Color fundus photograph.
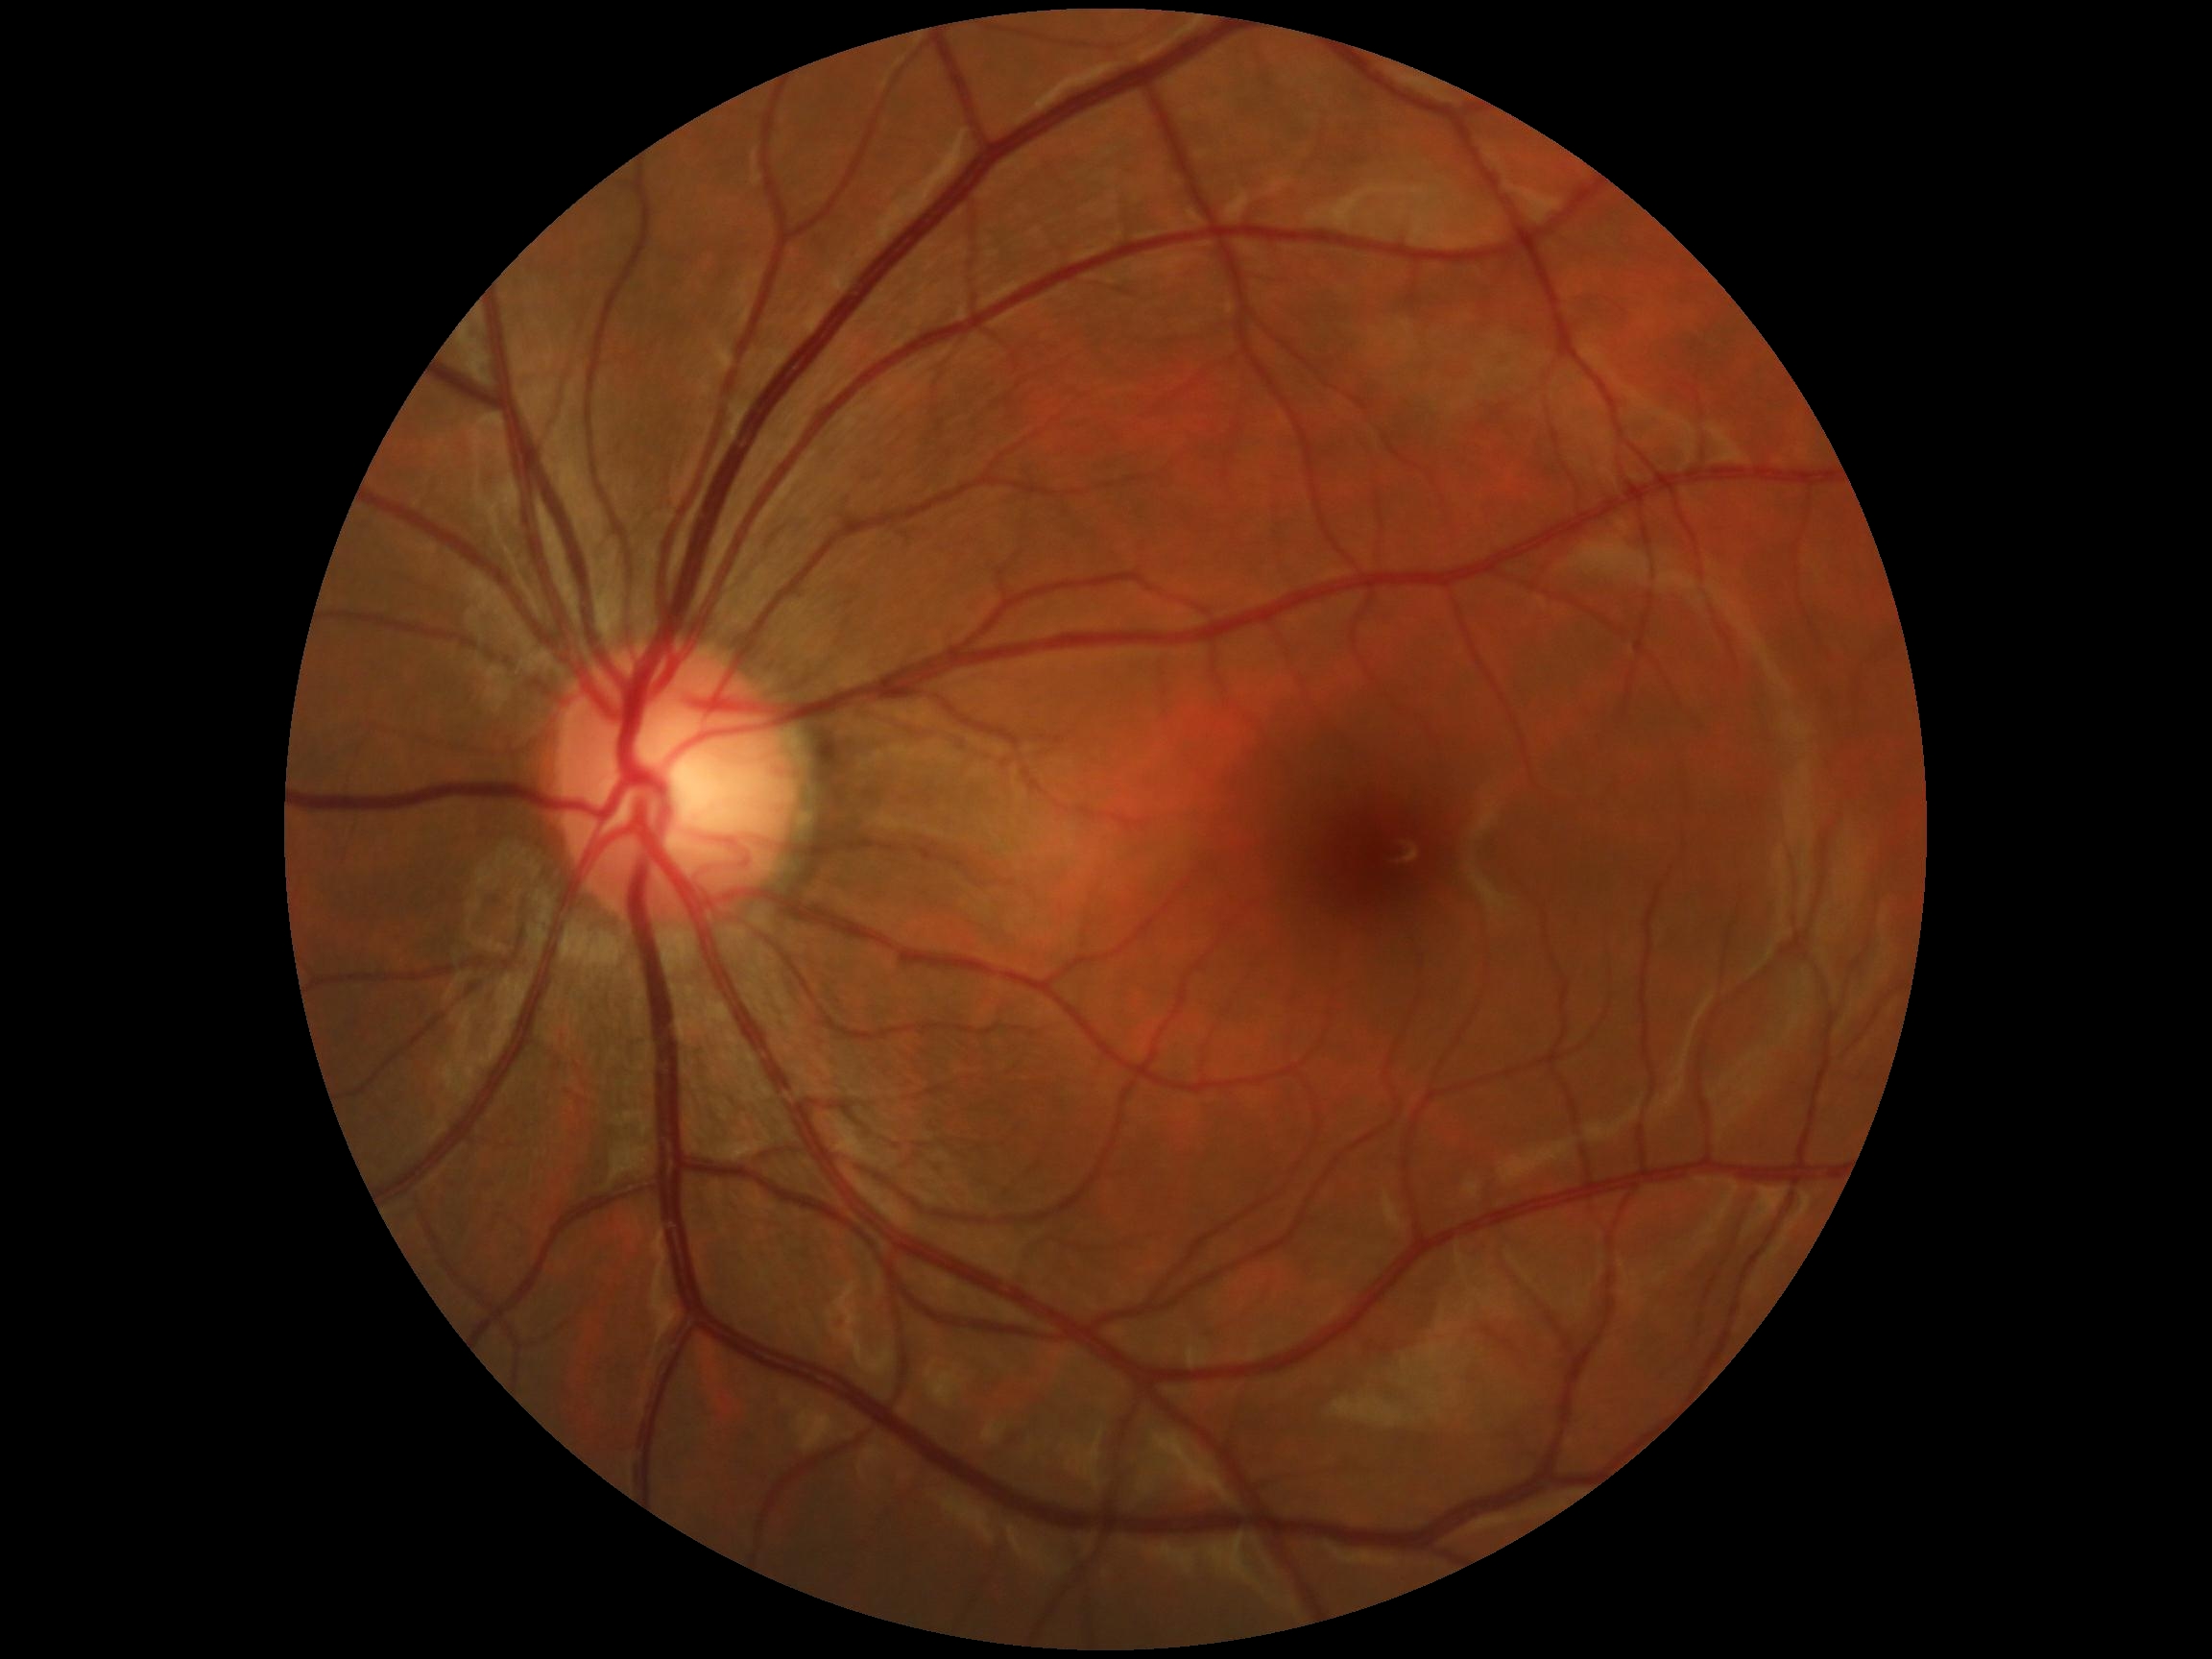 Annotations:
- diabetic retinopathy severity: grade 0 — no visible signs of diabetic retinopathy